Without pupil dilation. CFP — 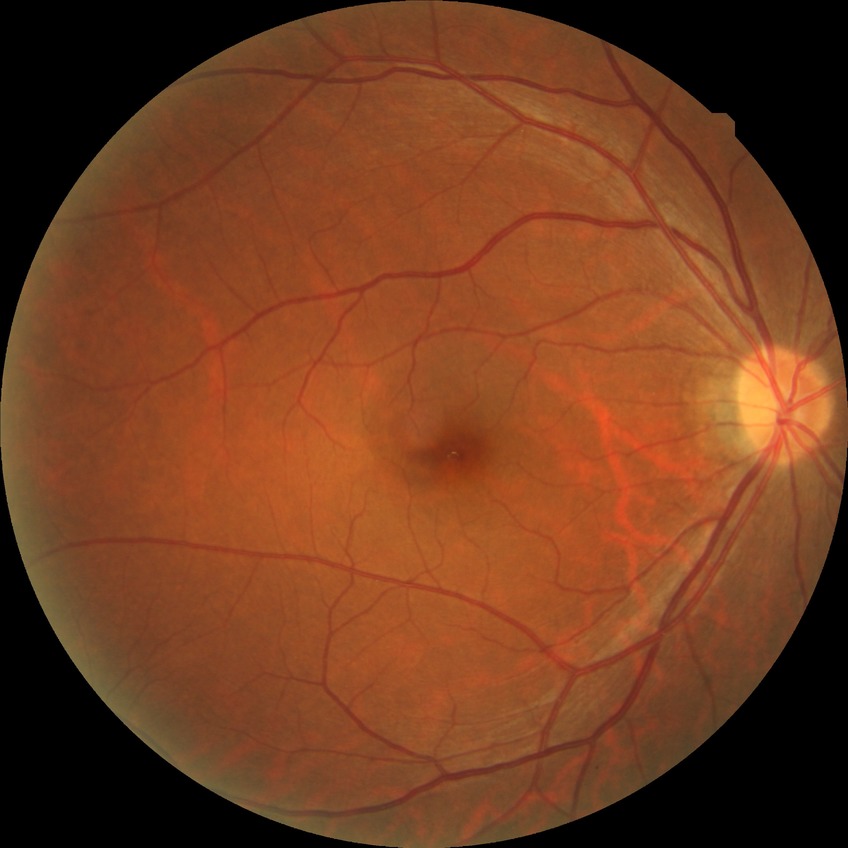
Davis DR grade: NDR.